Pediatric wide-field fundus photograph. 1240x1240px.
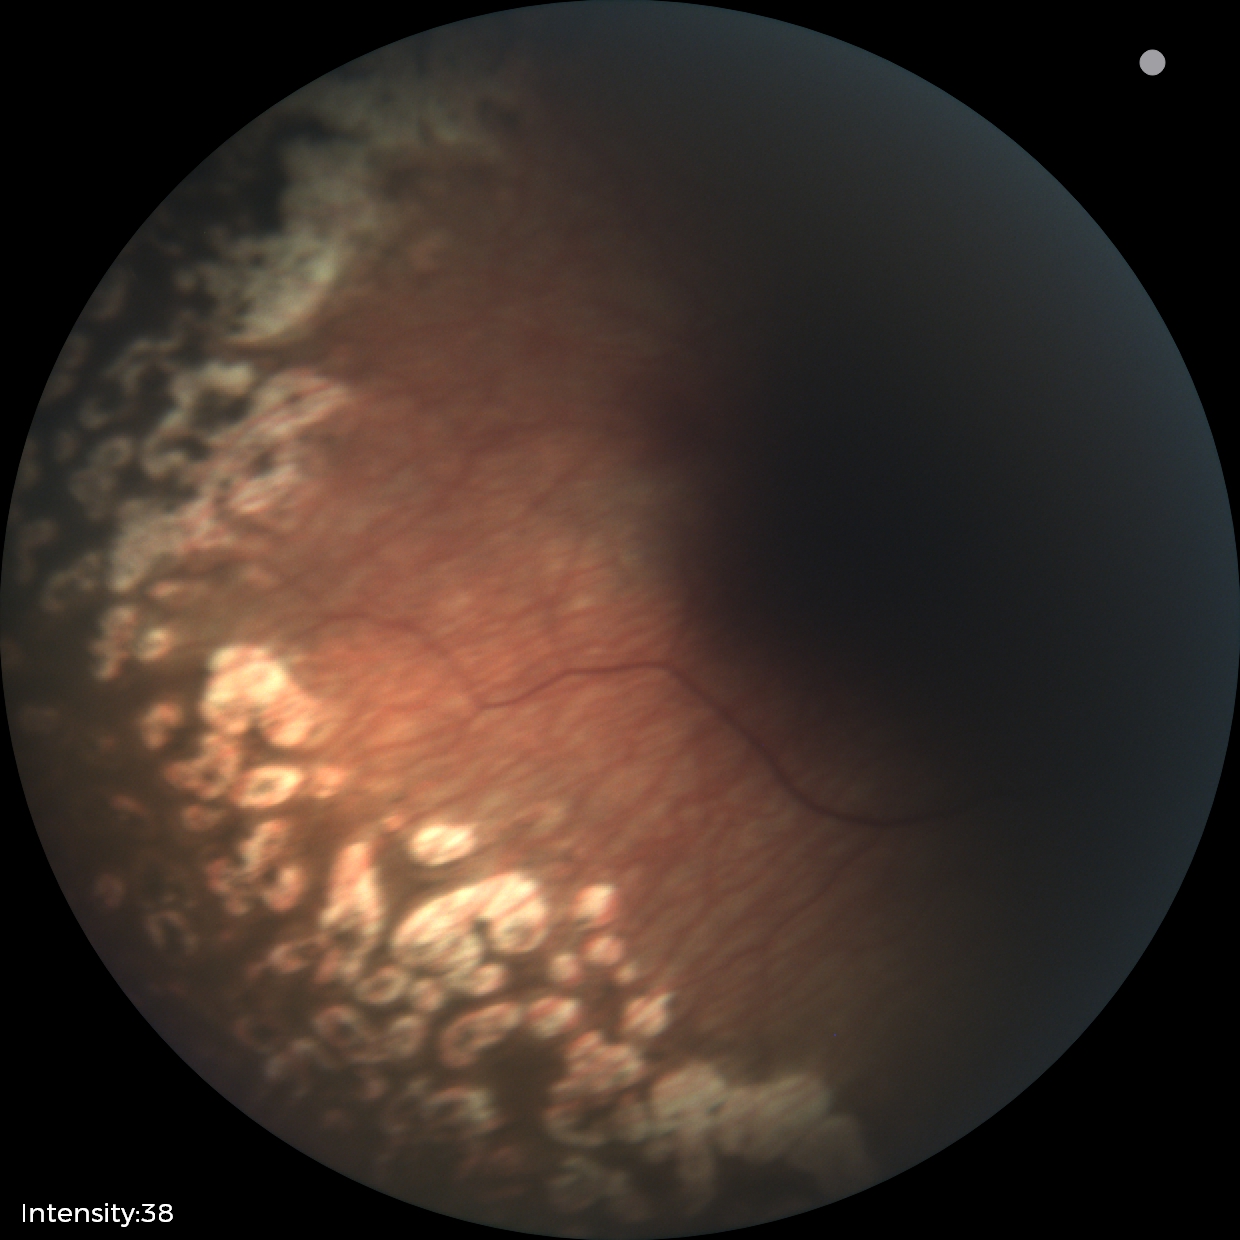
Plus disease absent. Screening examination consistent with status post retinopathy of prematurity.